FOV: 45 degrees; 2212x1659:
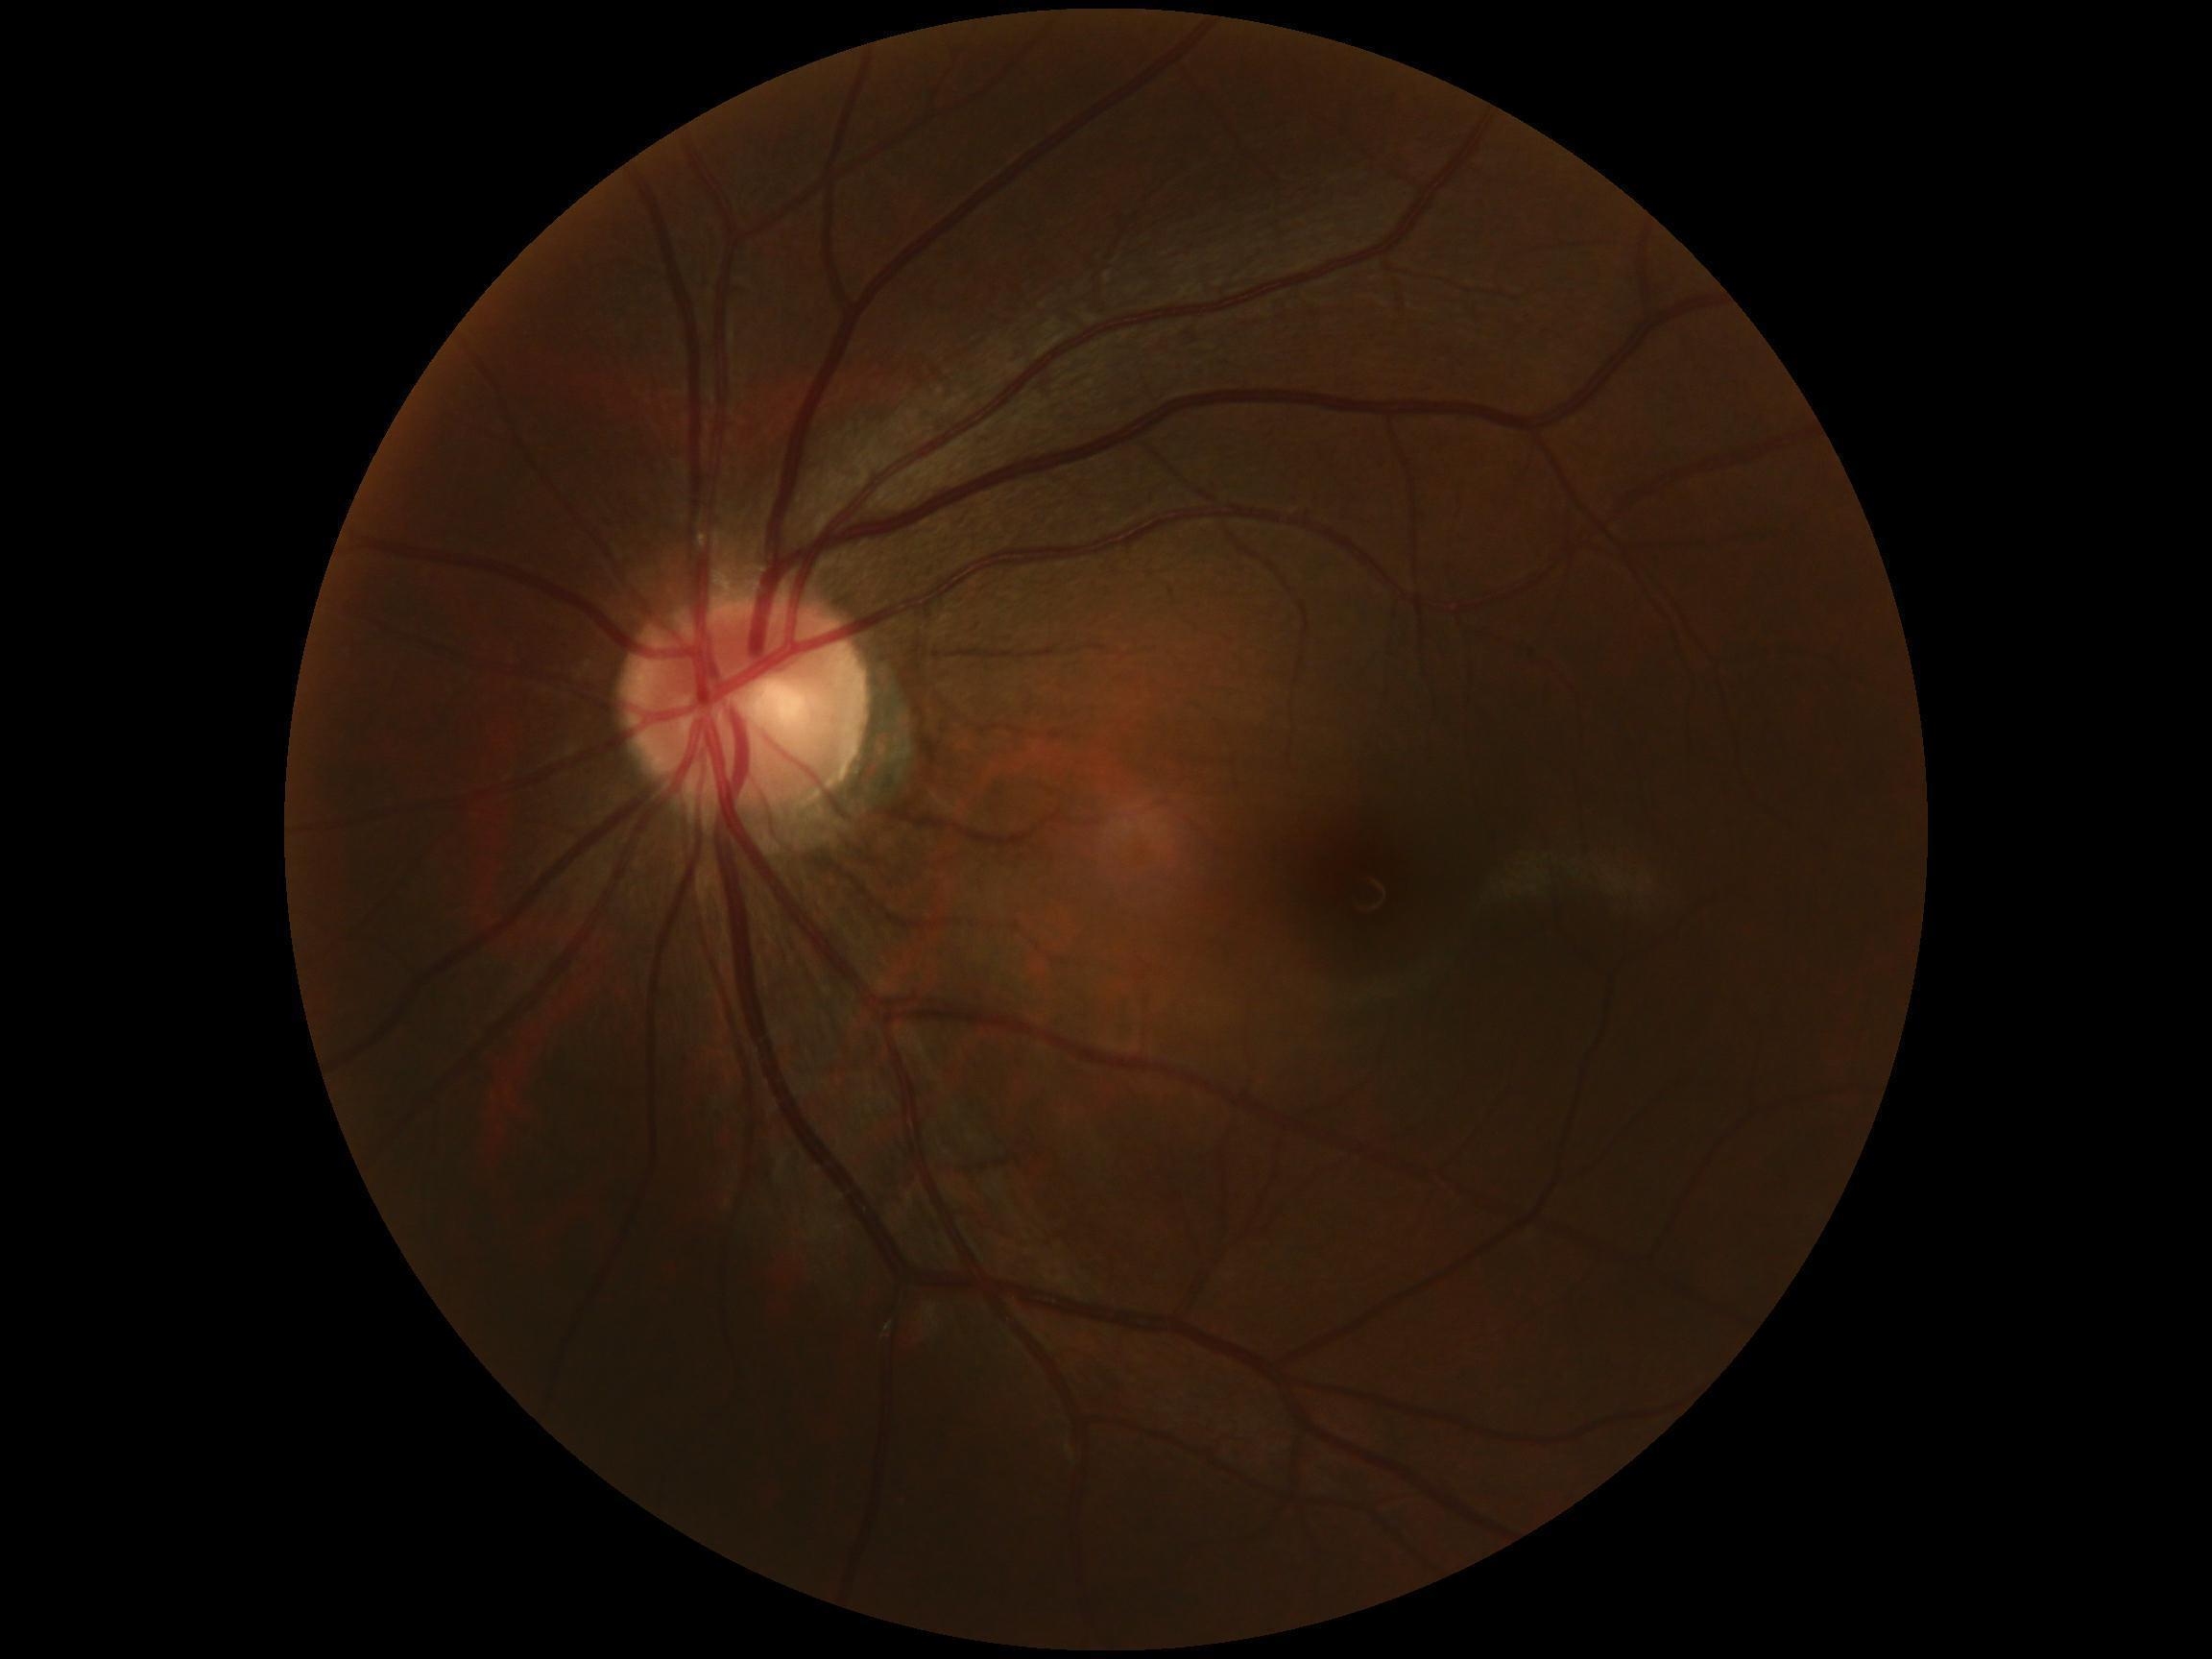
Annotations:
- diabetic retinopathy — grade 0 (no apparent retinopathy)